45° FOV.
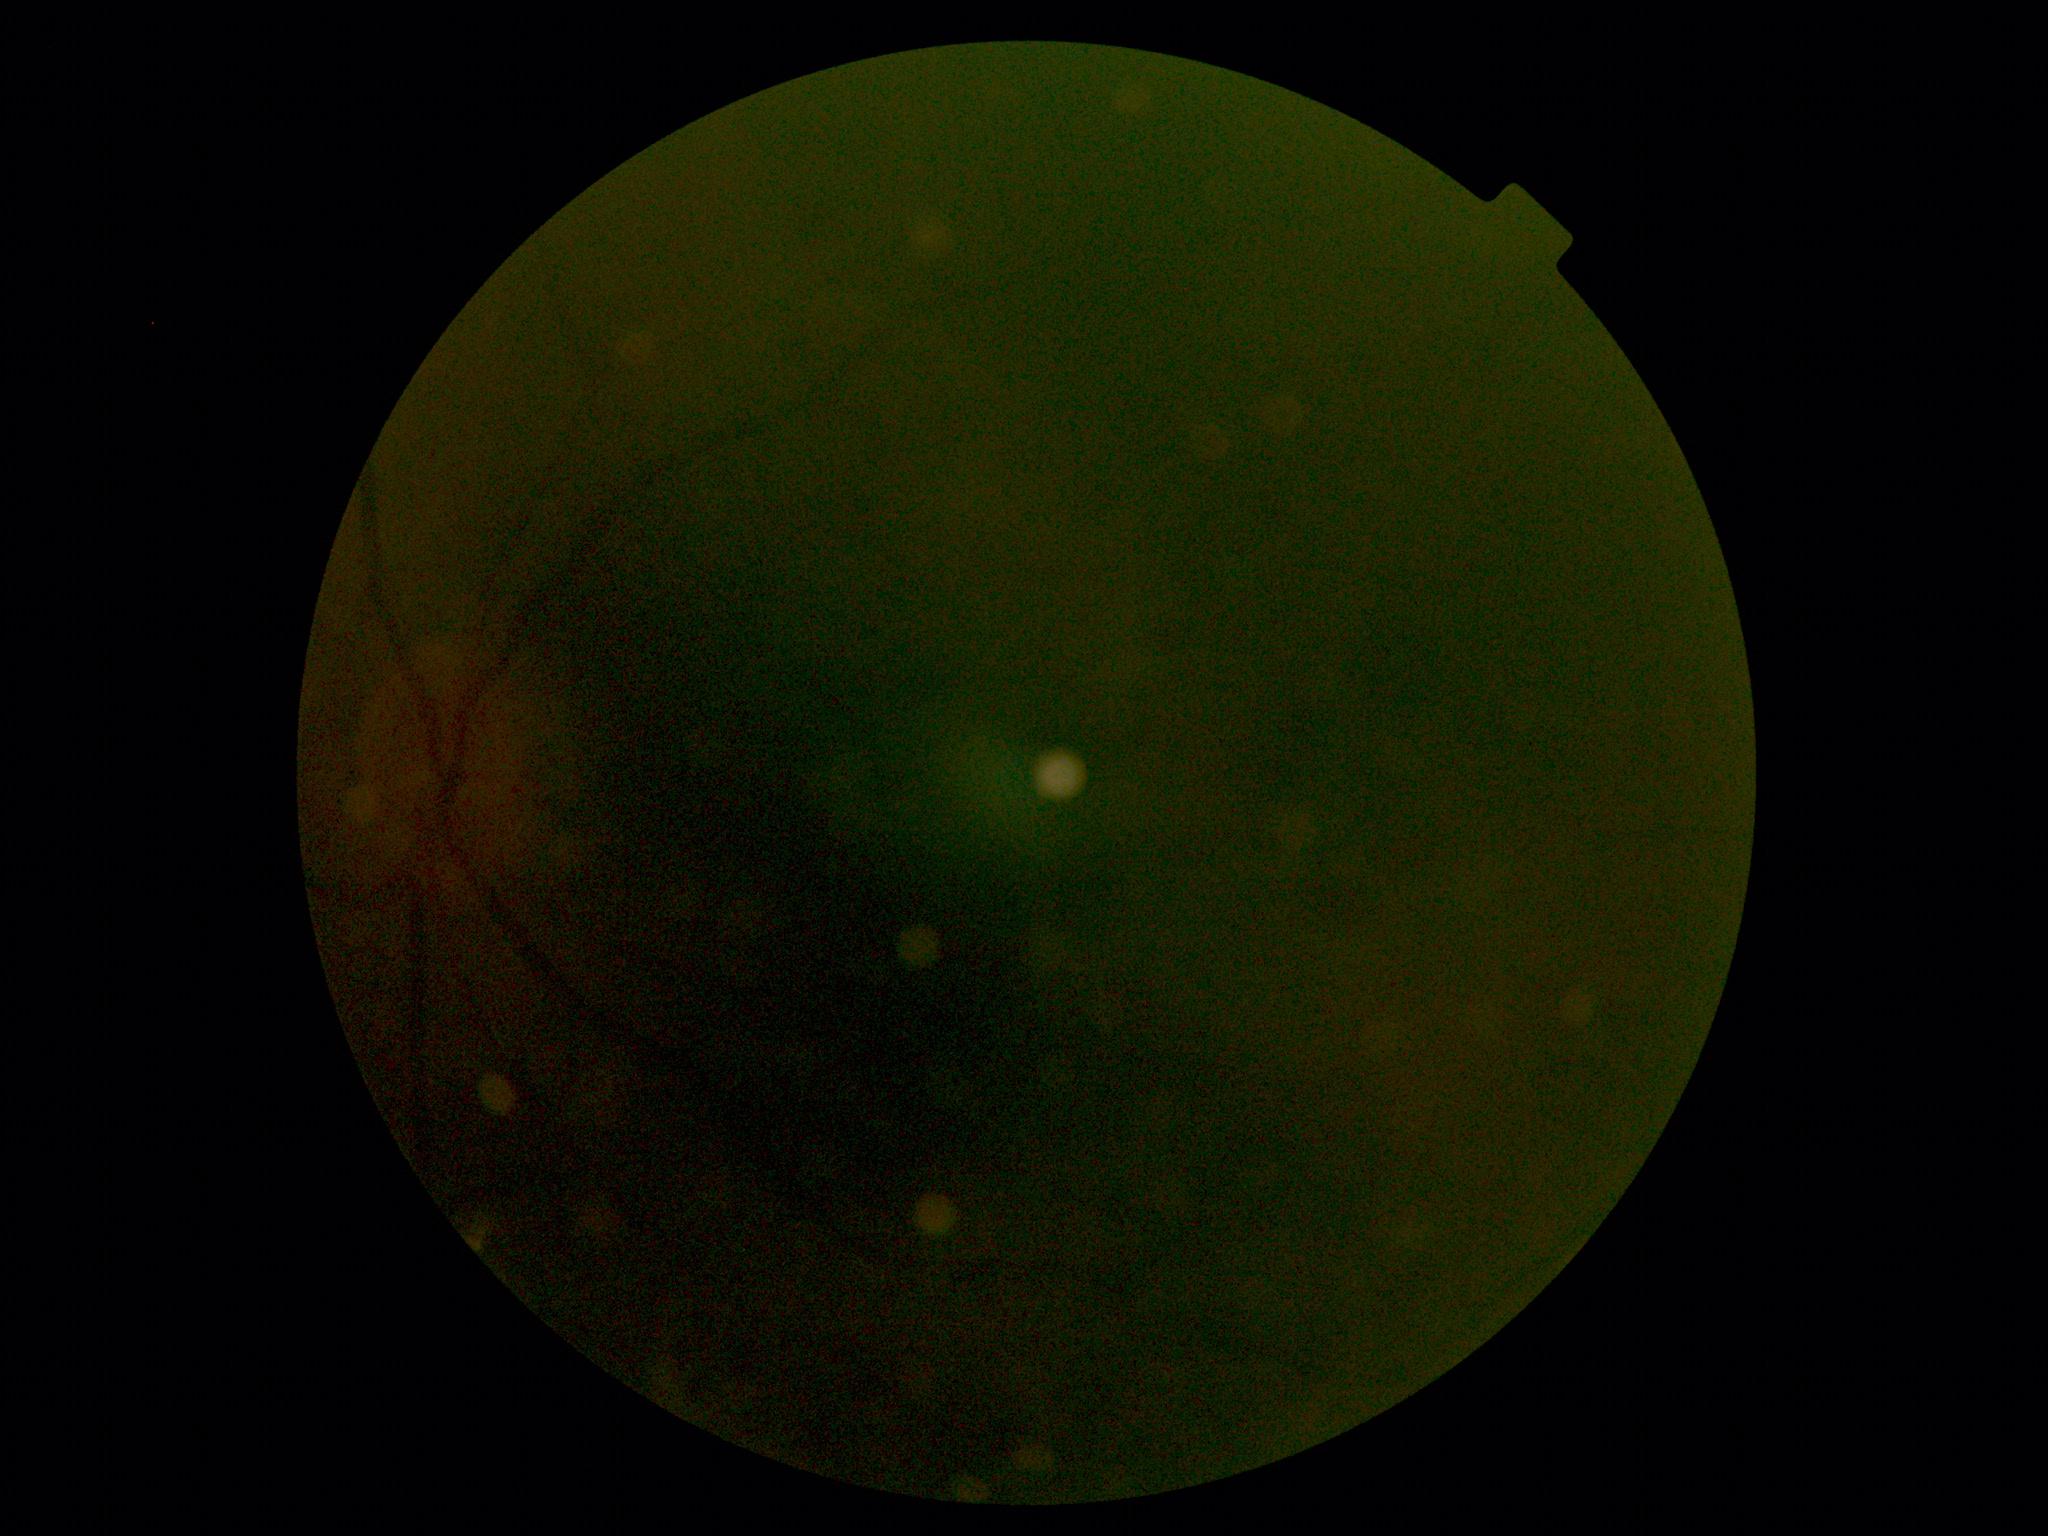 DR@ungradable due to poor image quality.